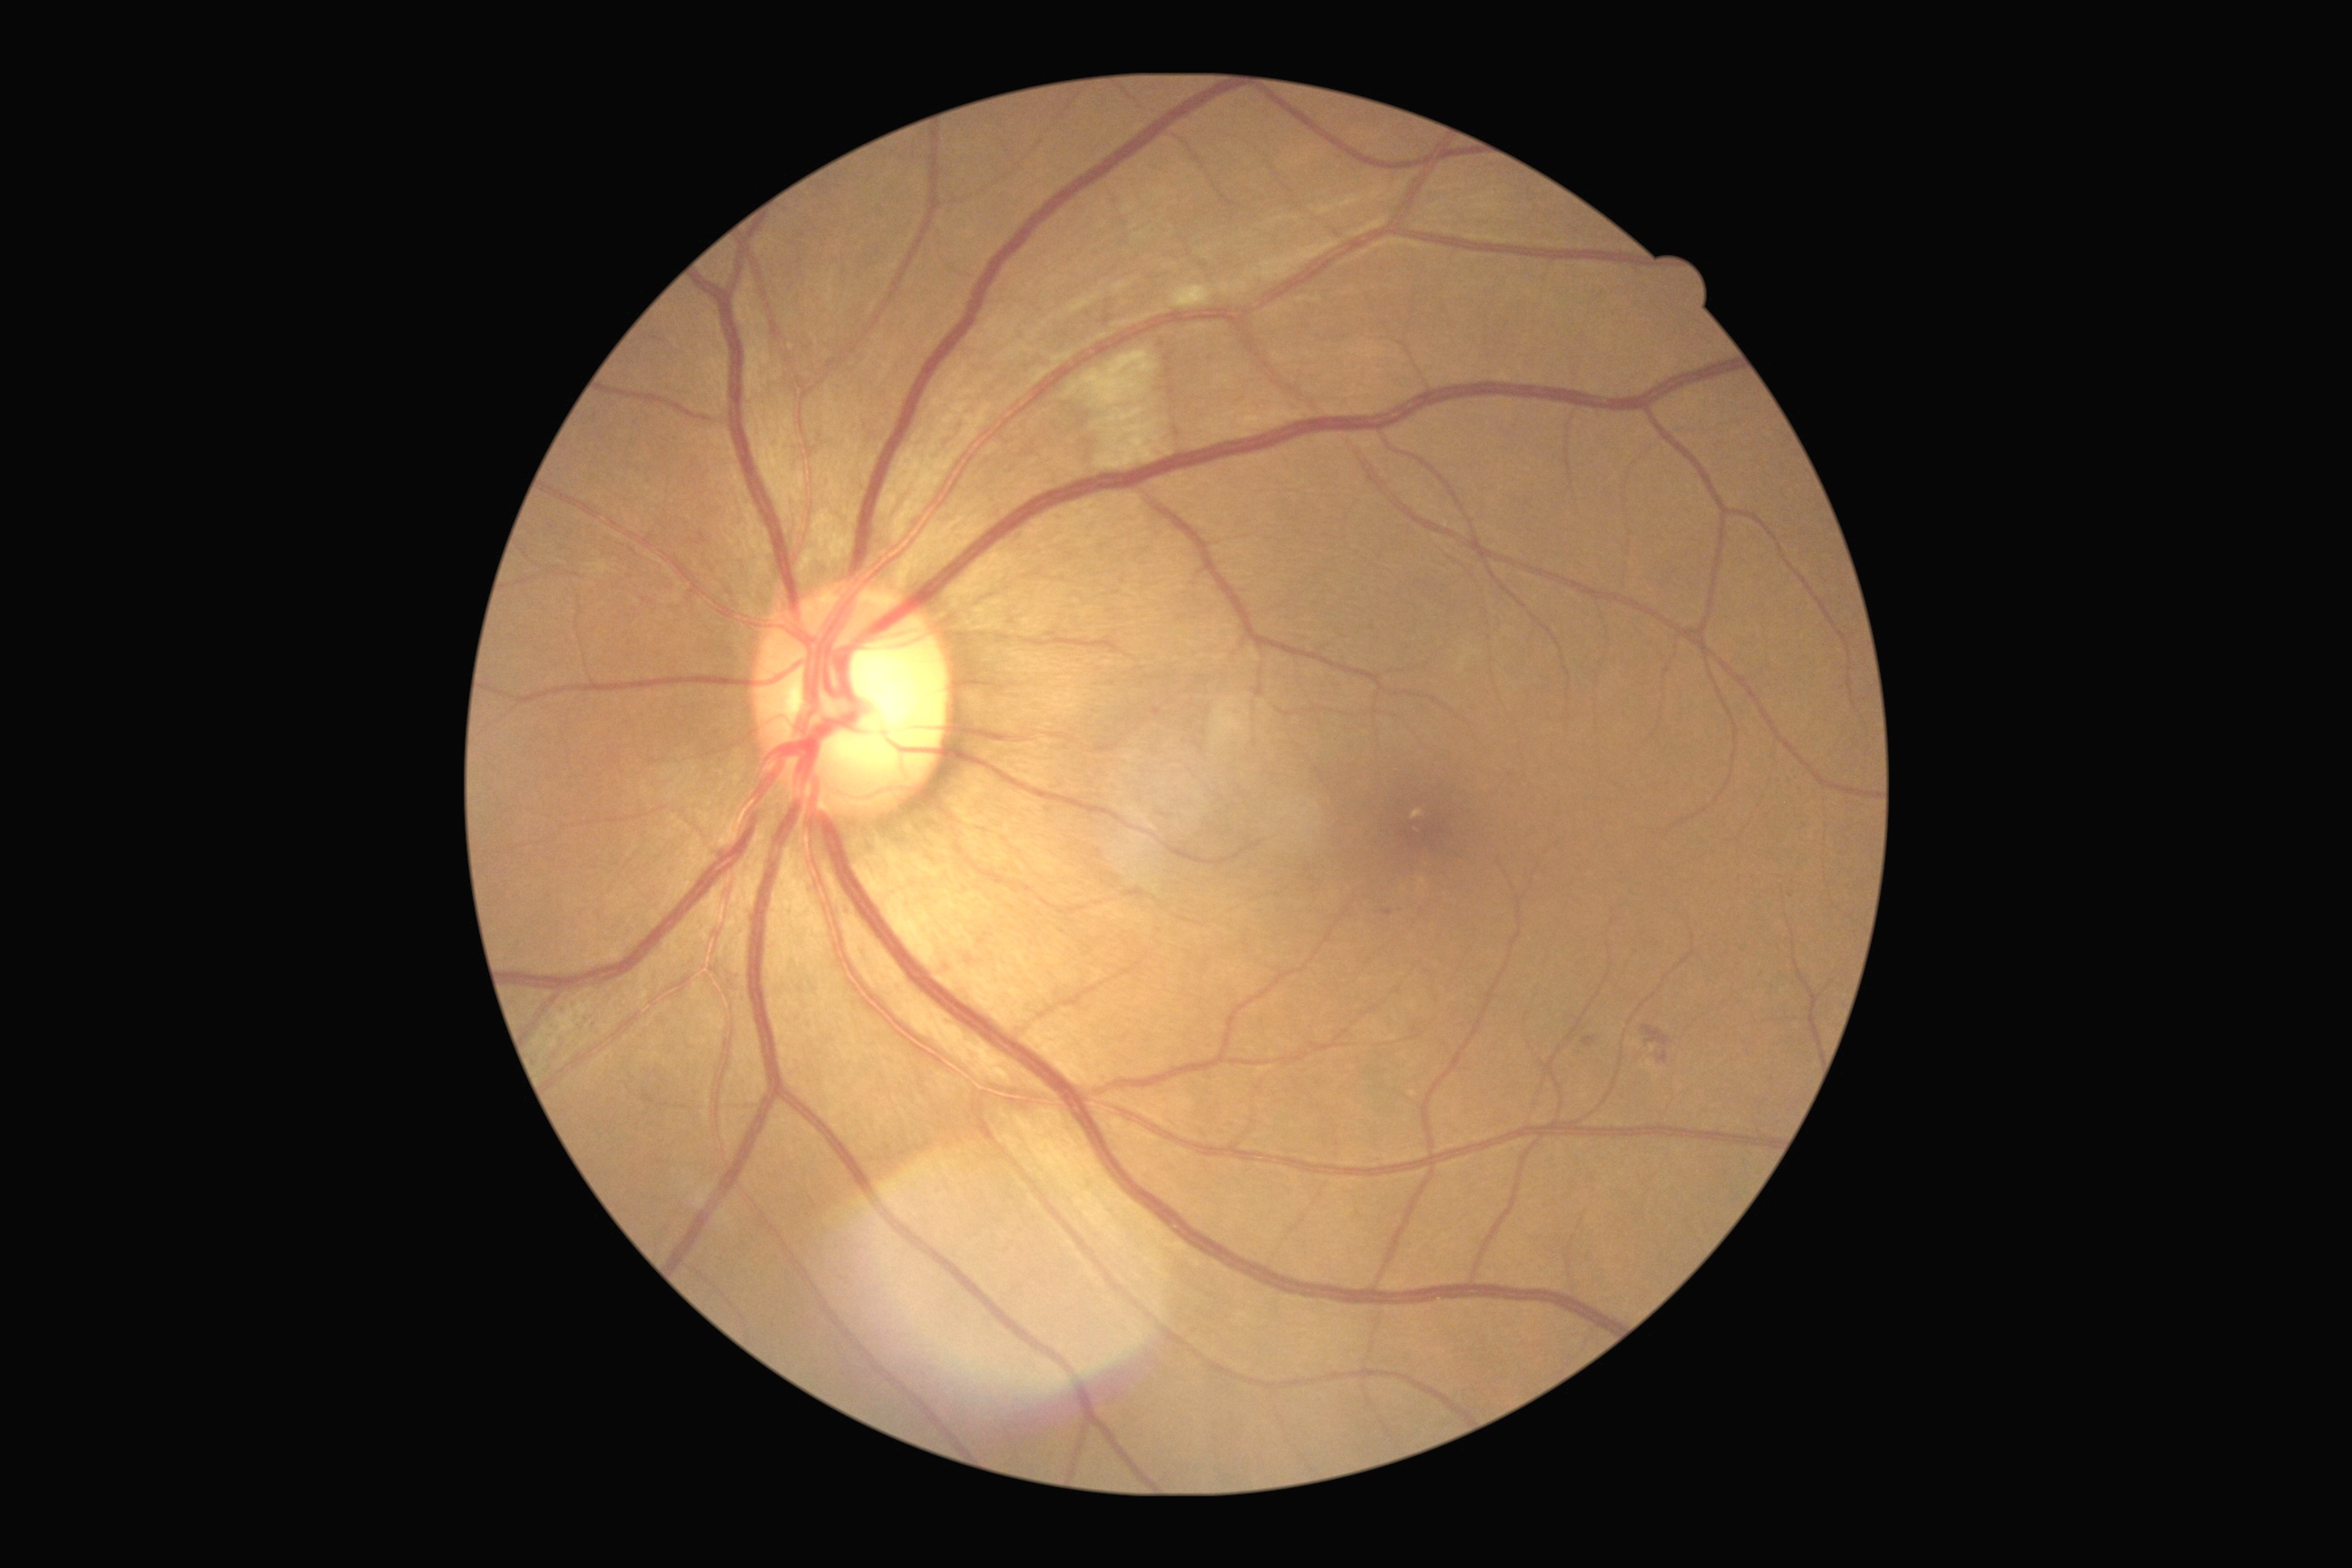

DR stage: grade 2 (moderate NPDR) — more than just microaneurysms but less than severe NPDR.